Remidio smartphone fundus camera; color fundus image
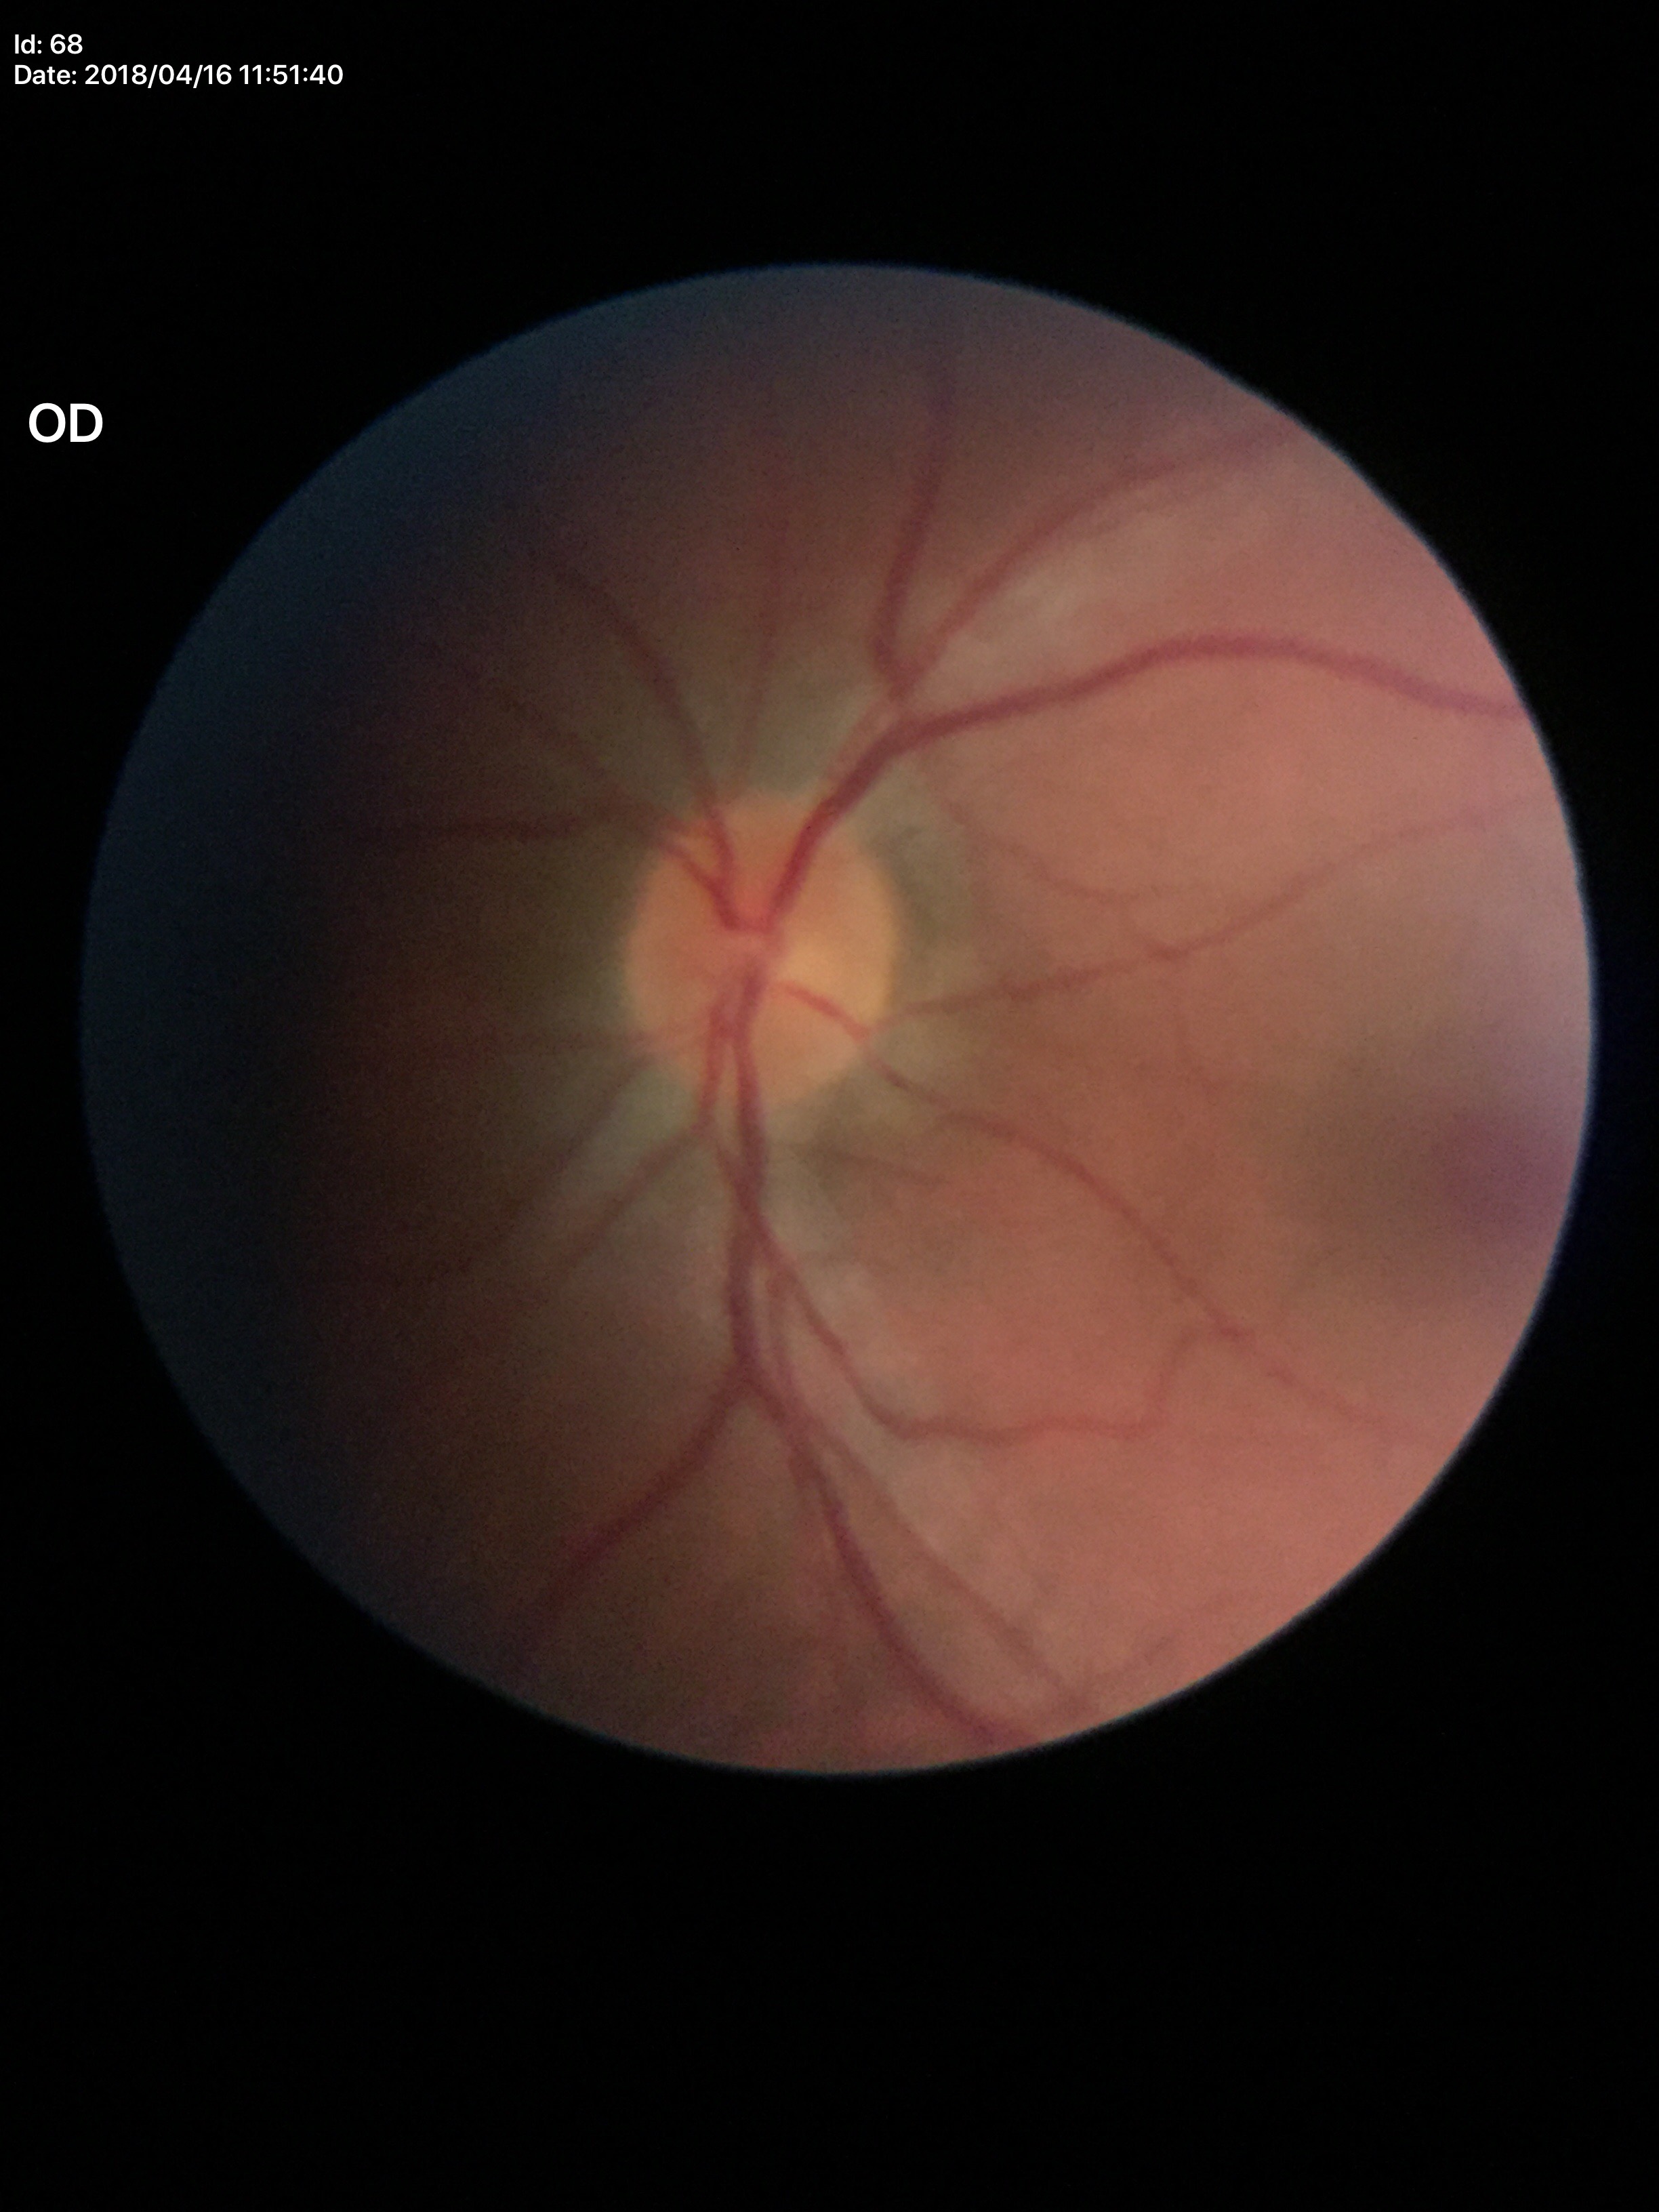 Negative for glaucoma suspicion. Vertical cup-to-disc ratio is 0.40.